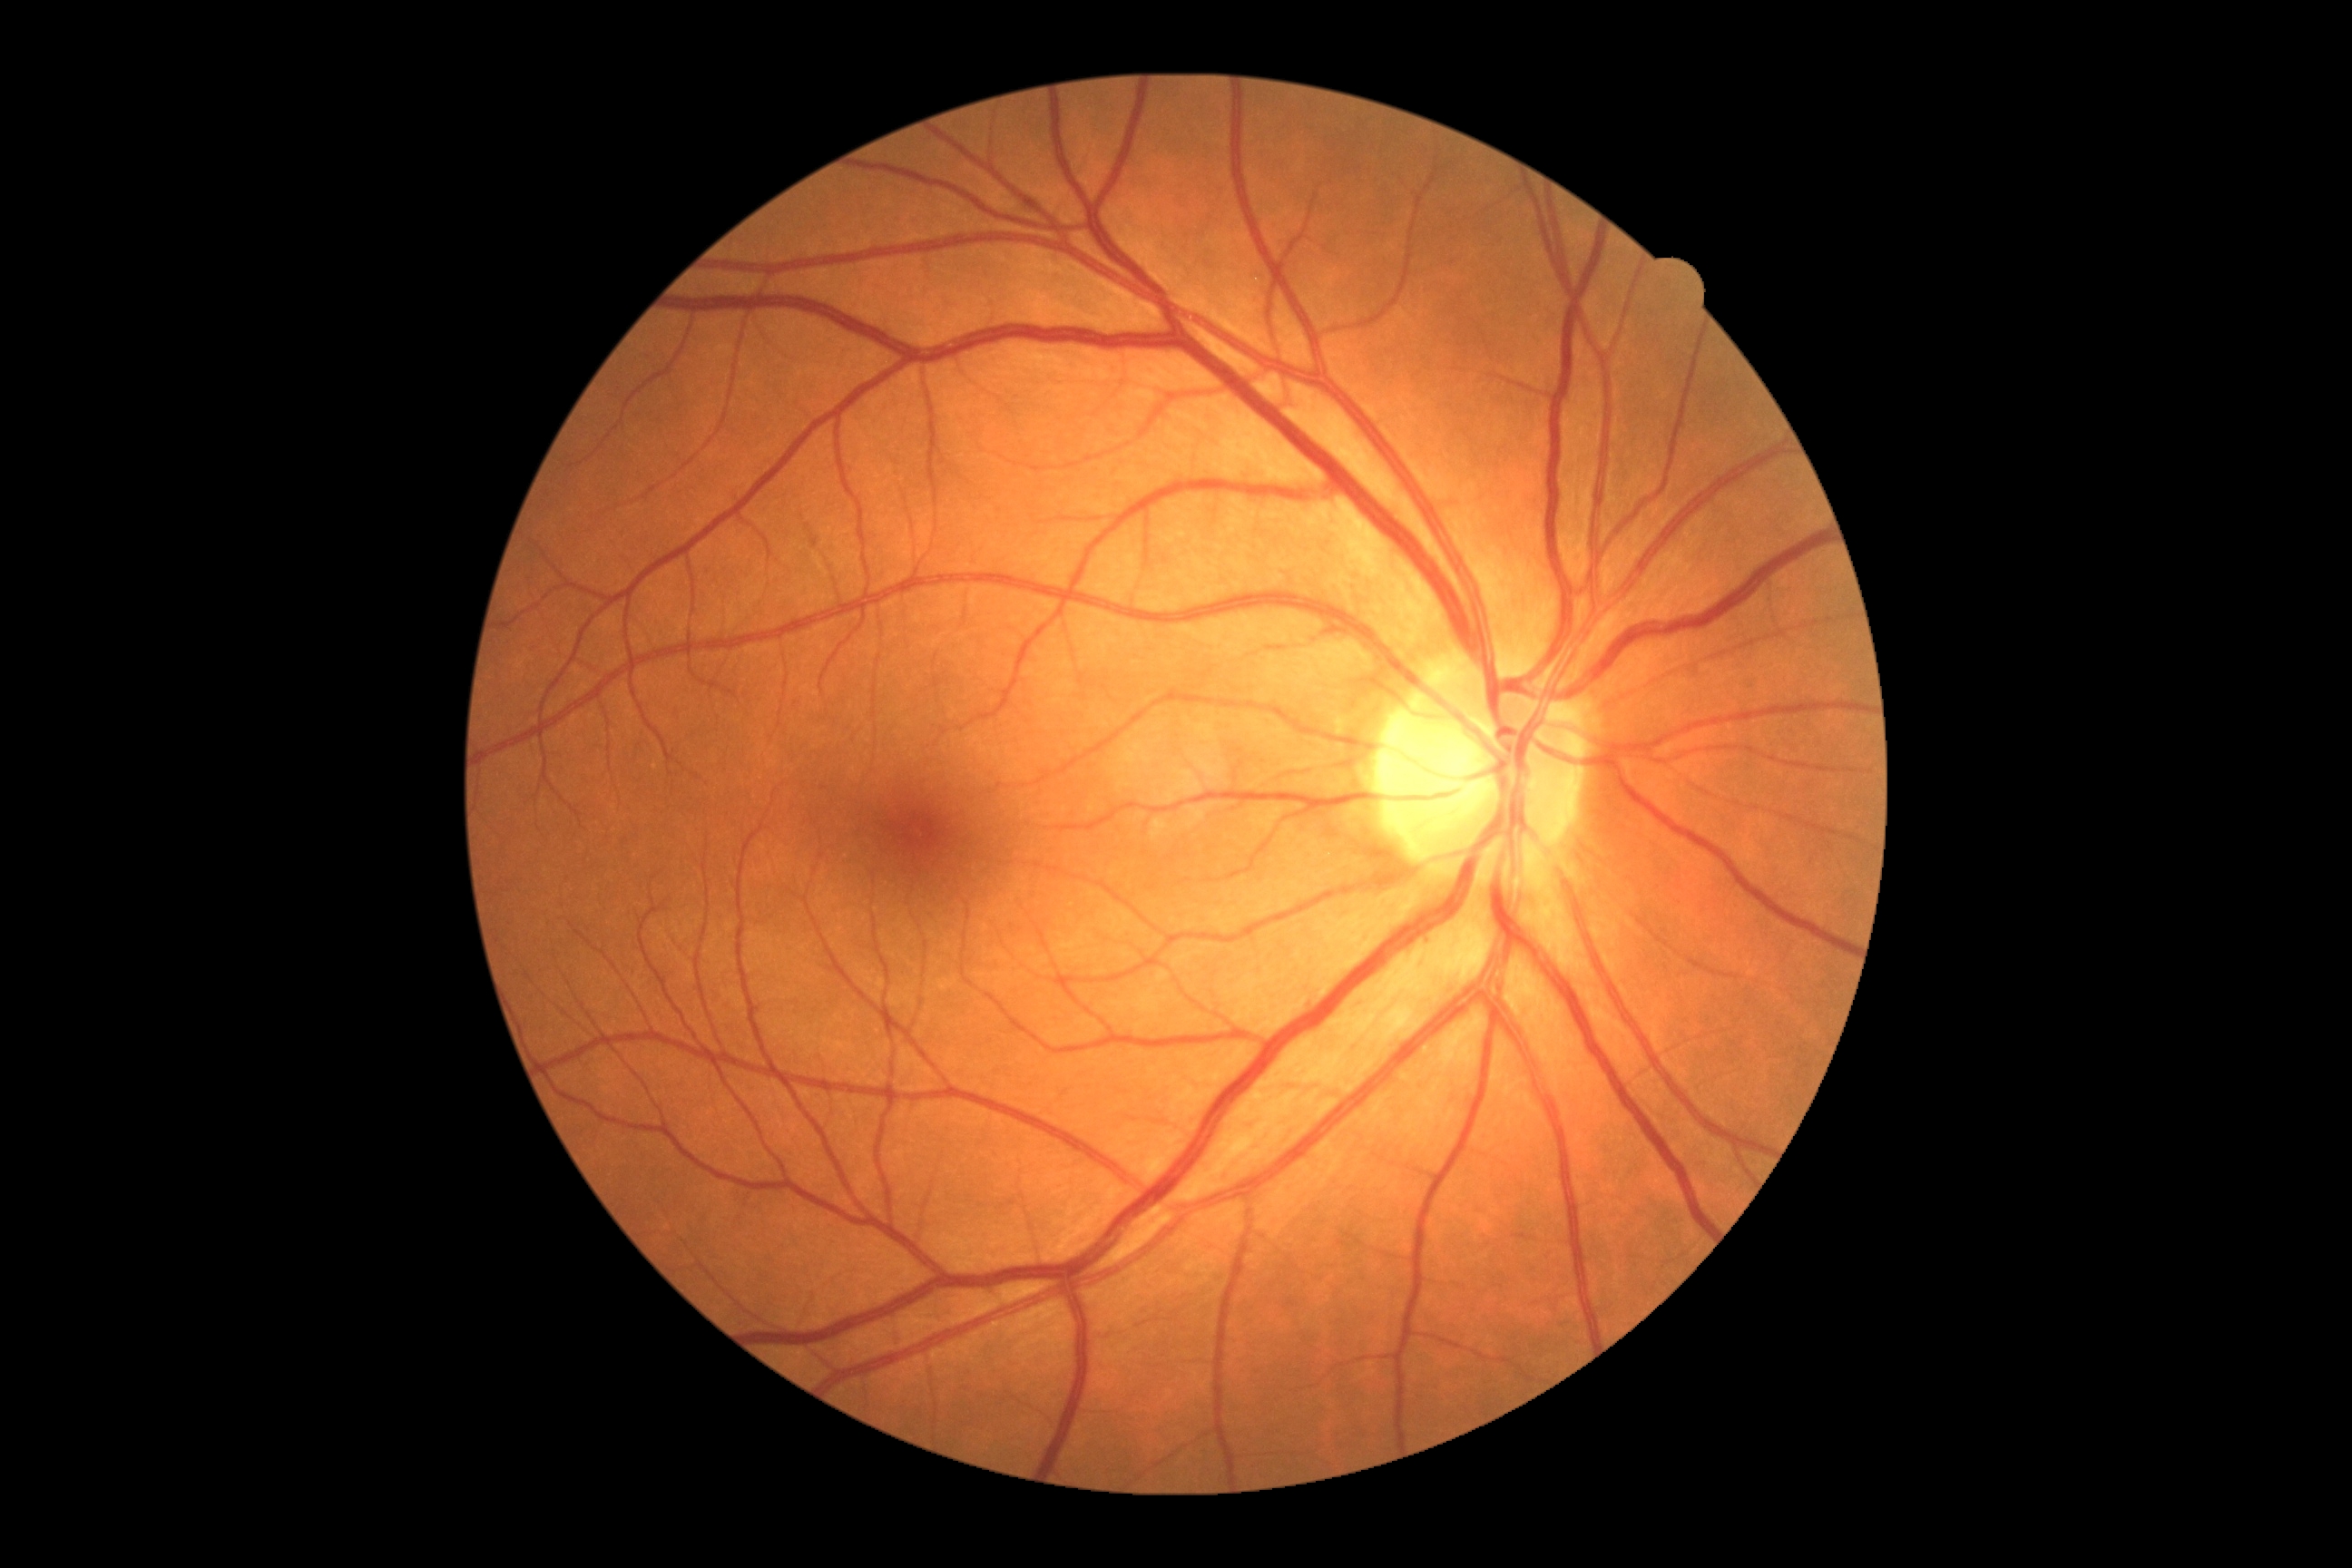 DR grade=0.